Retinal fundus photograph — 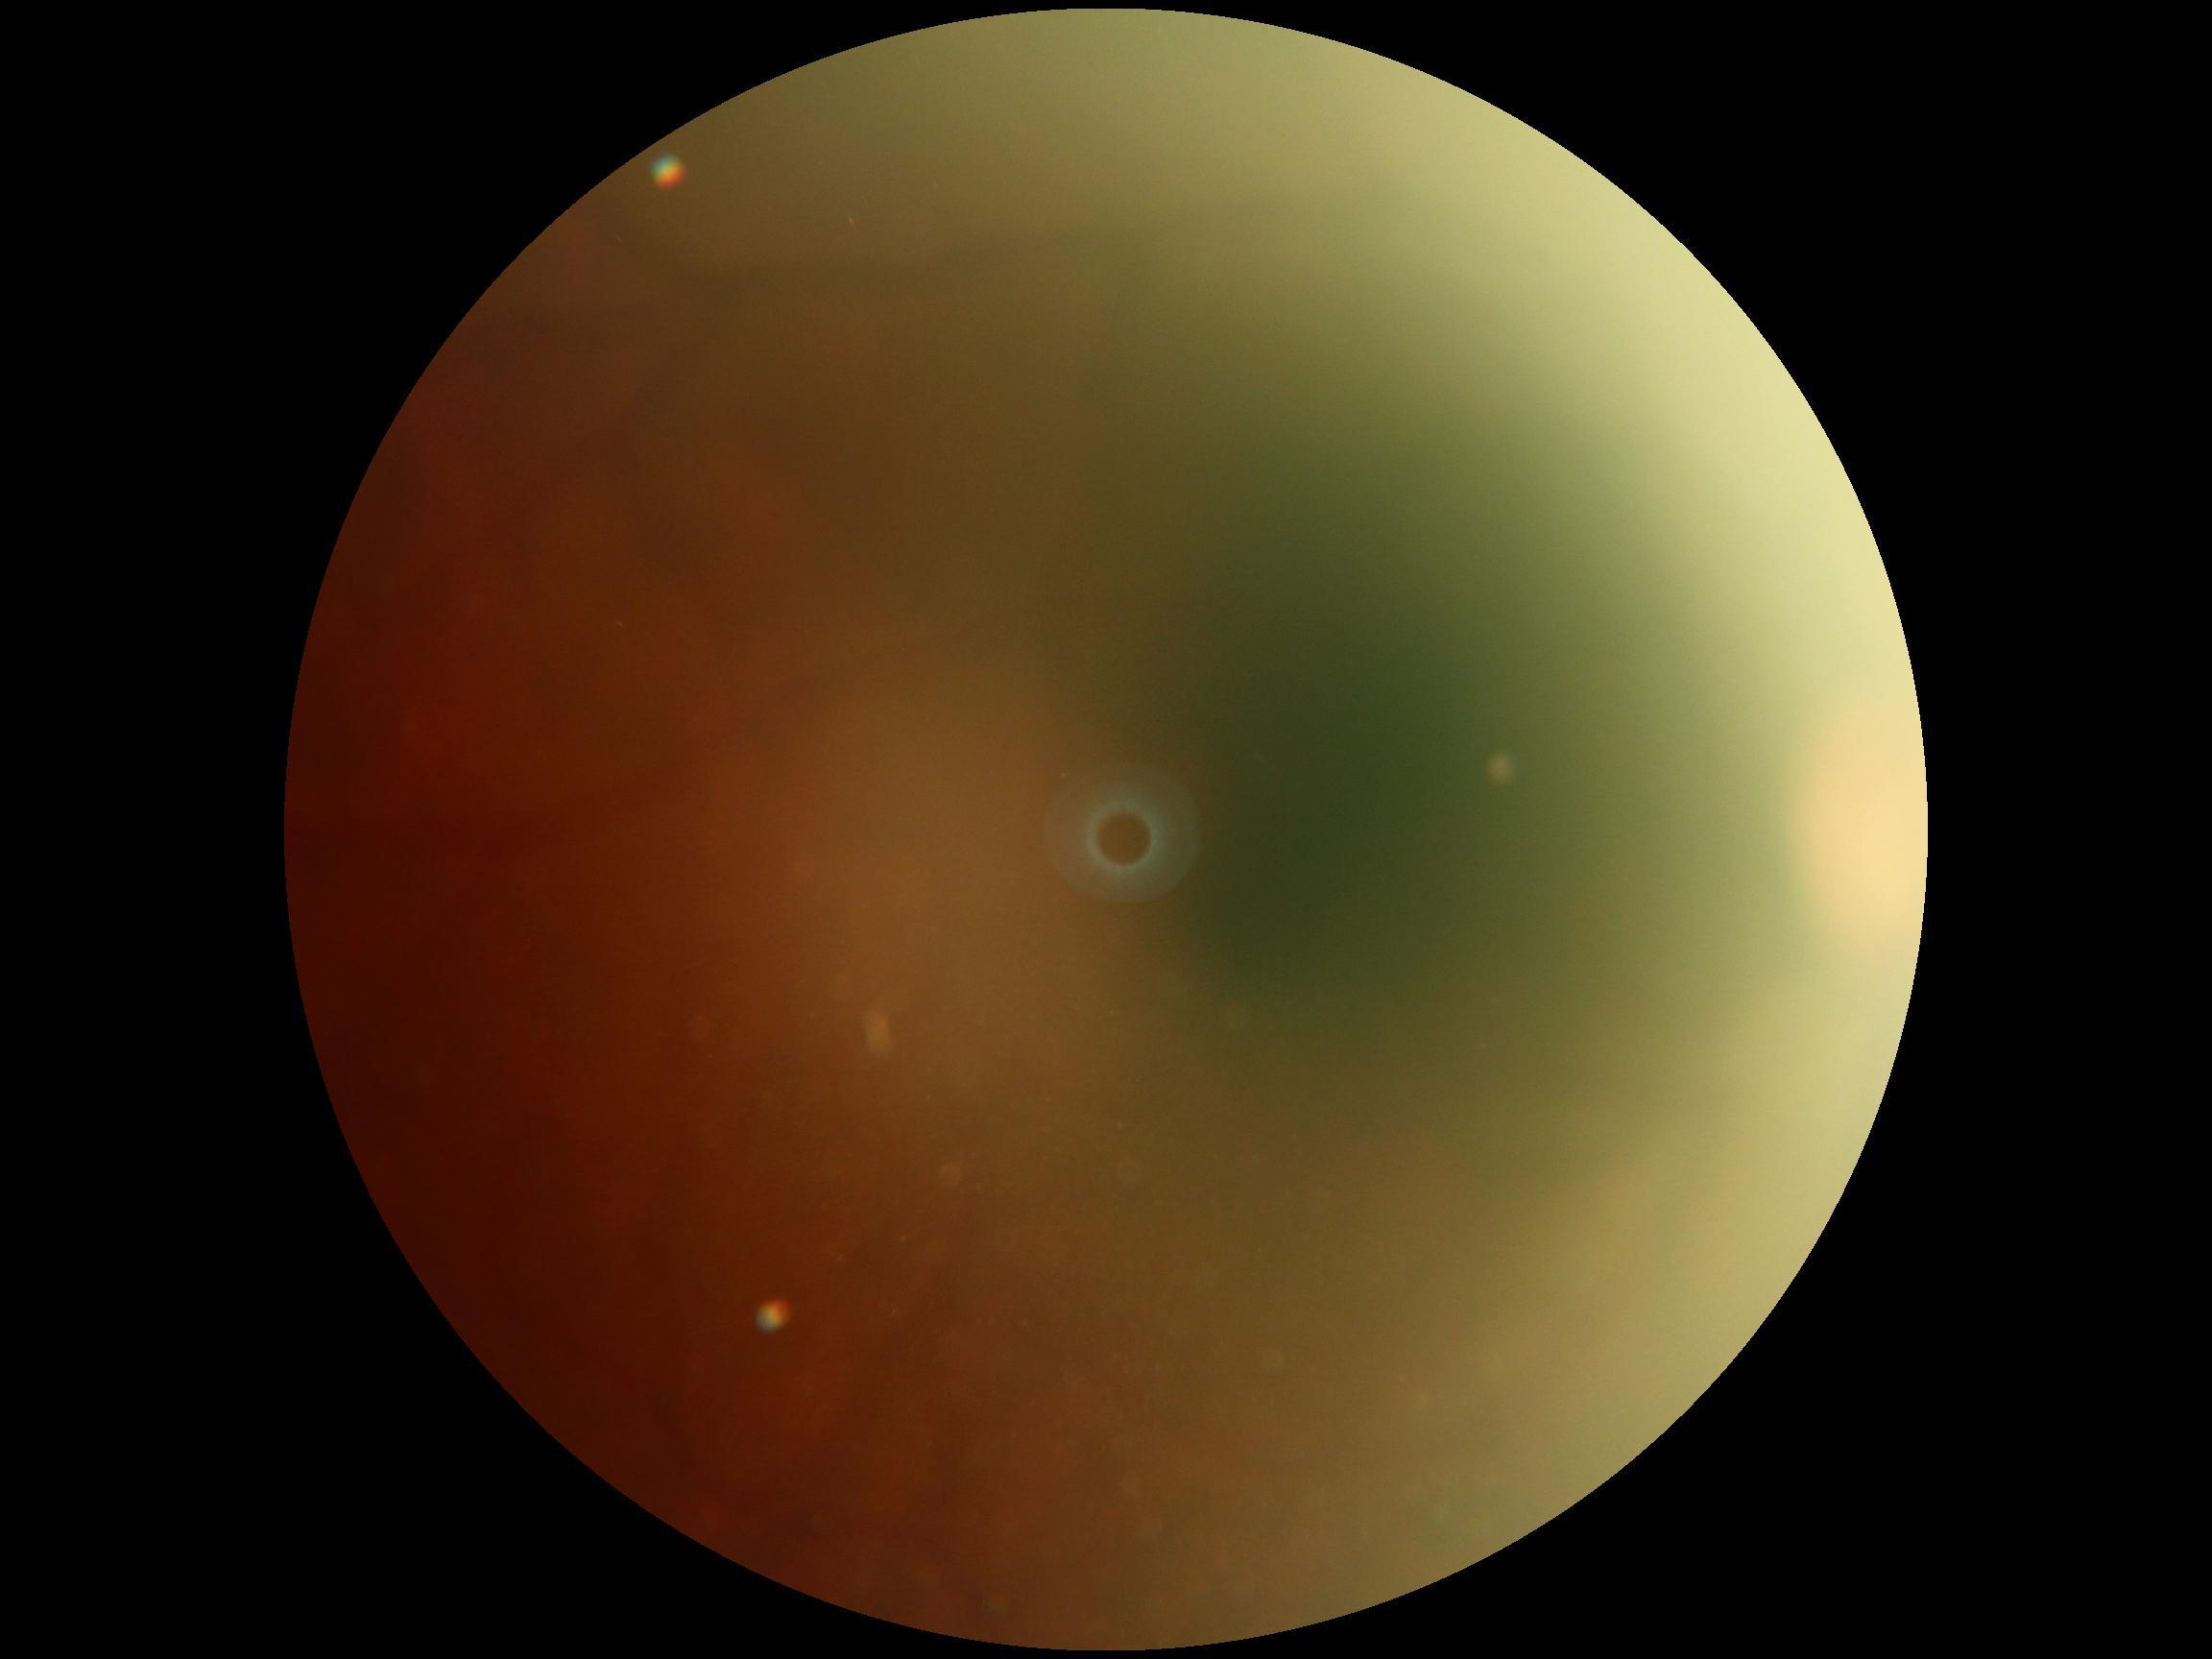

Diabetic retinopathy (DR) is ungradable.